CFP; sex: male; pachymetry: 546 µm.
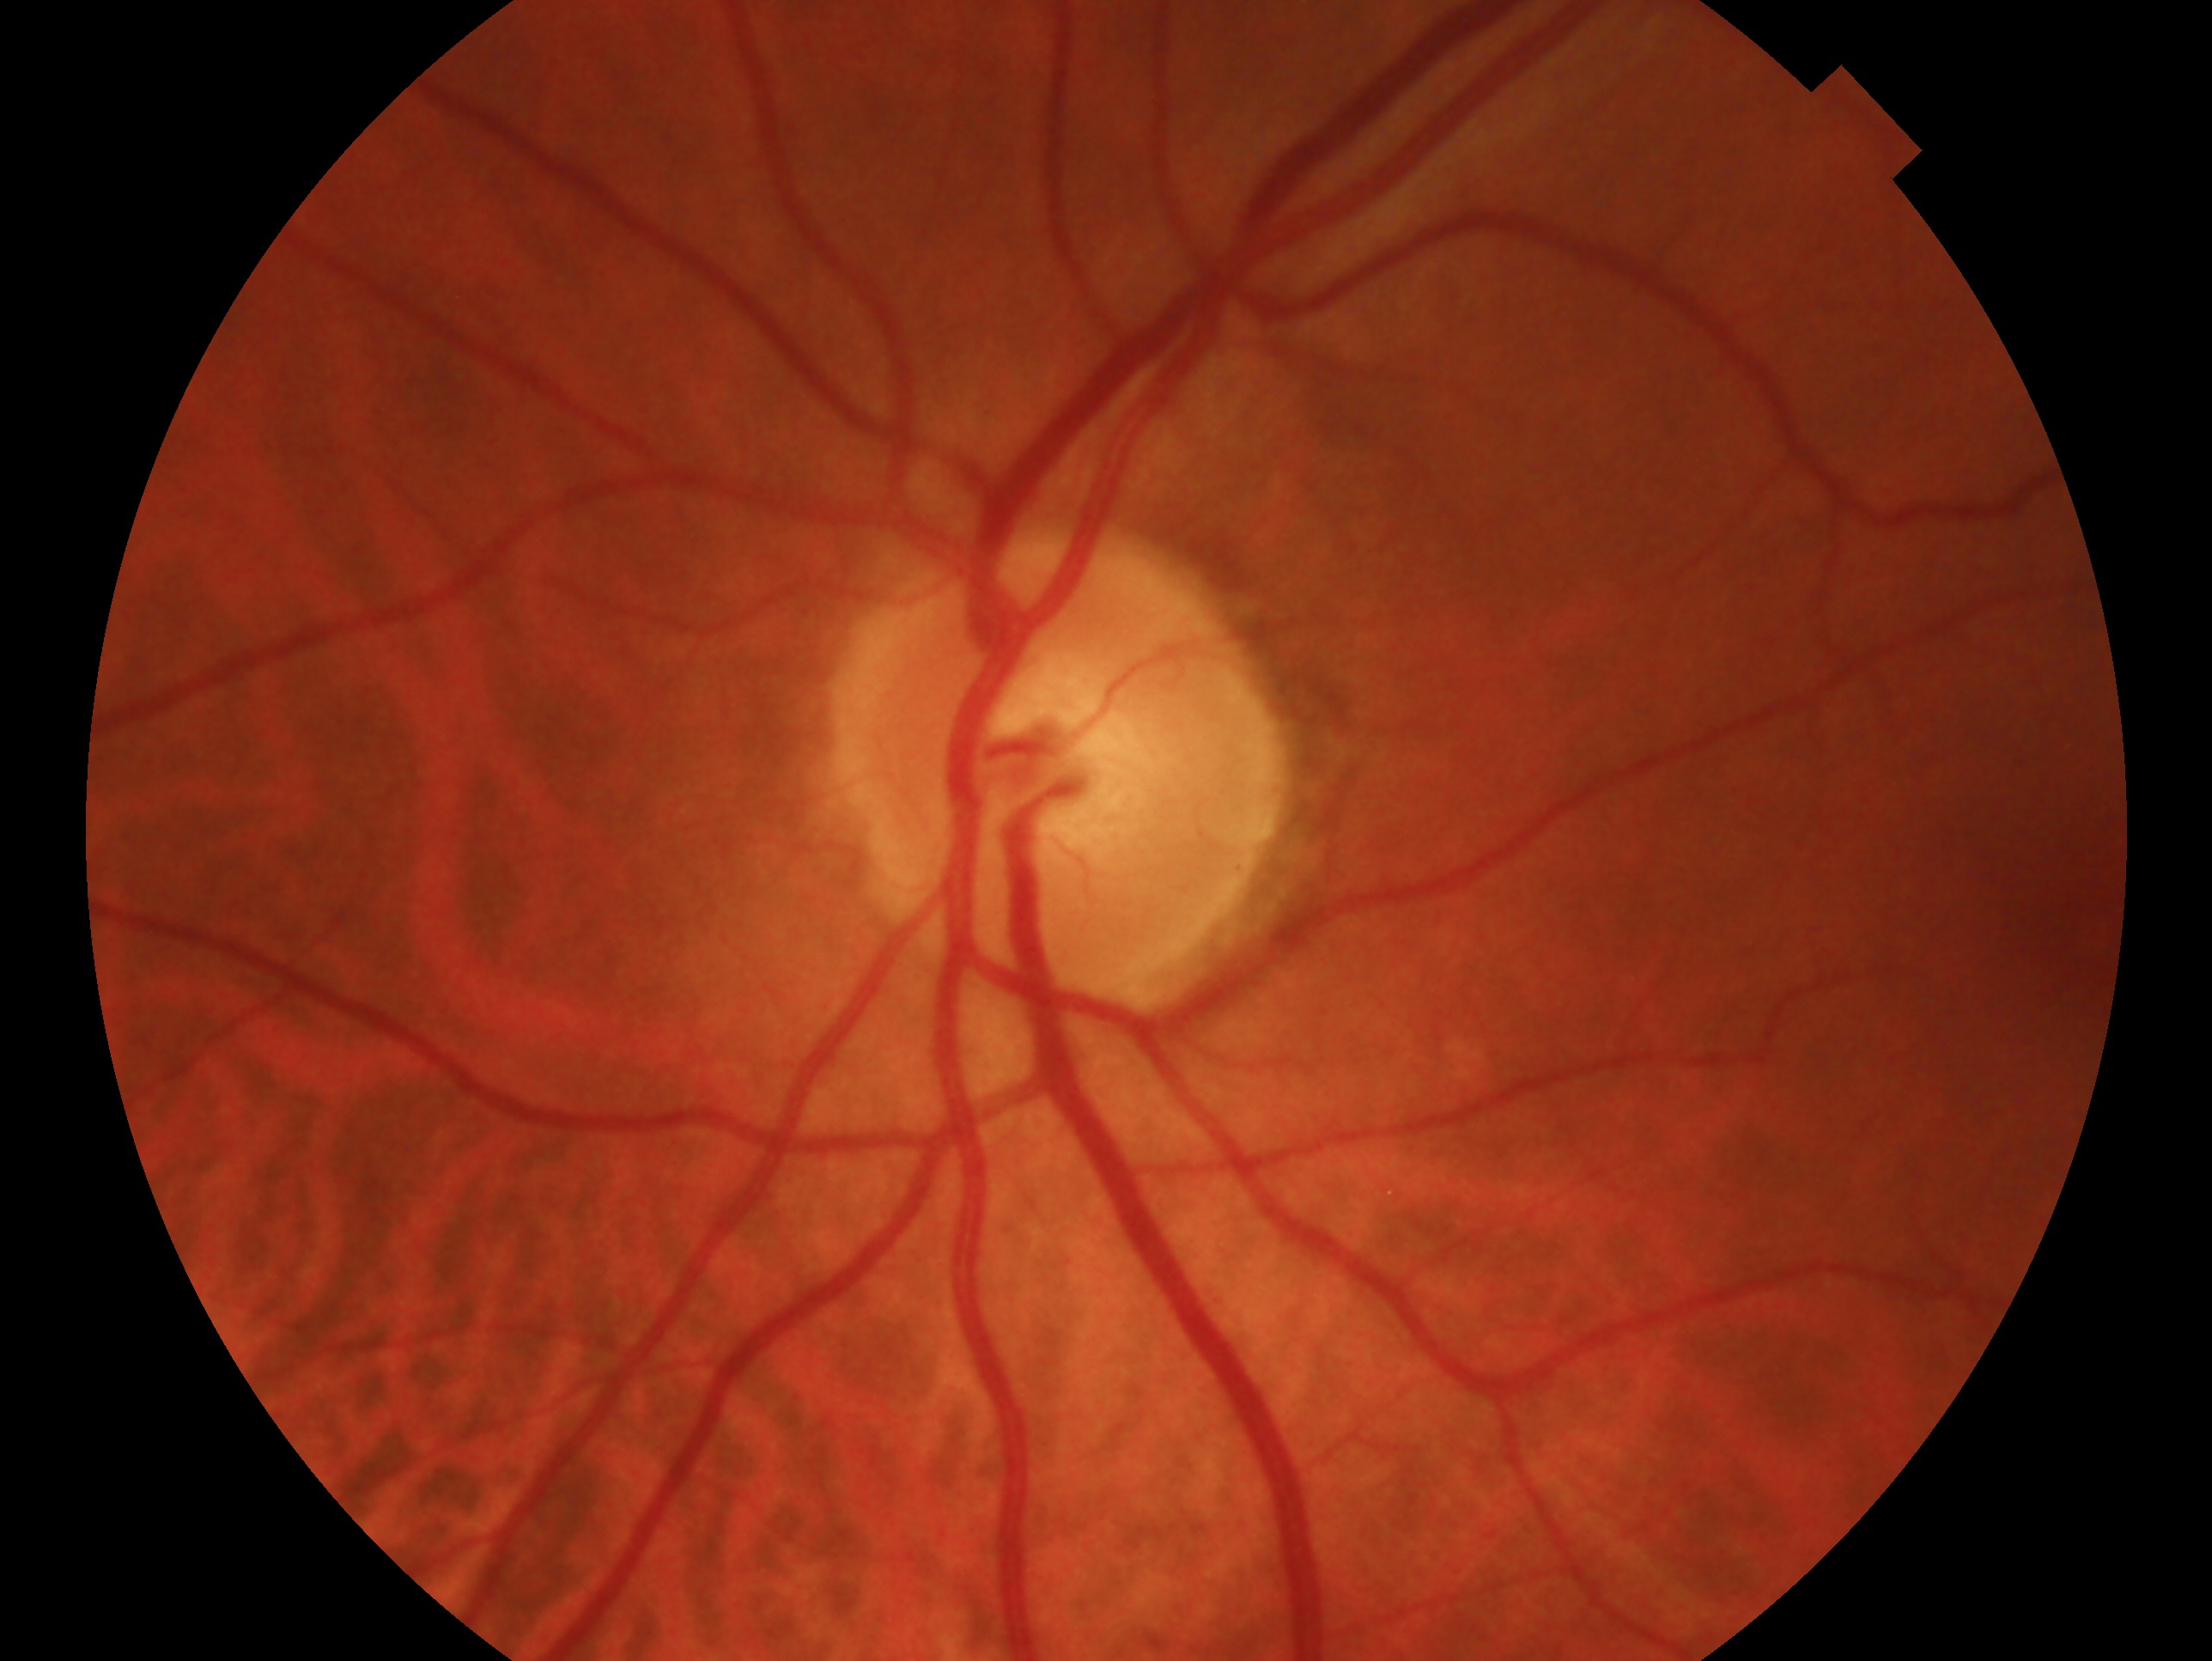 Q: Right or left eye?
A: left eye
Q: Glaucoma classification?
A: no signs of glaucoma